Cropped from a 35-degree field of view · ONH-centered crop from a color fundus image: 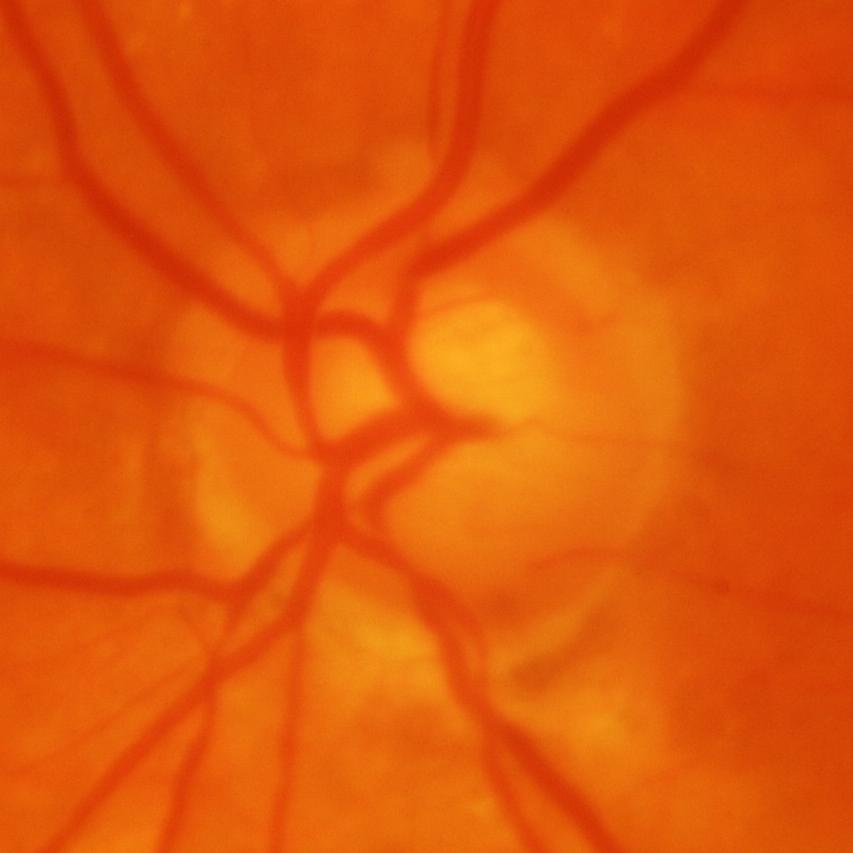
Glaucomatous changes are present.
Glaucomatous damage to the optic nerve.